1240x1240px; wide-field fundus photograph from neonatal ROP screening.
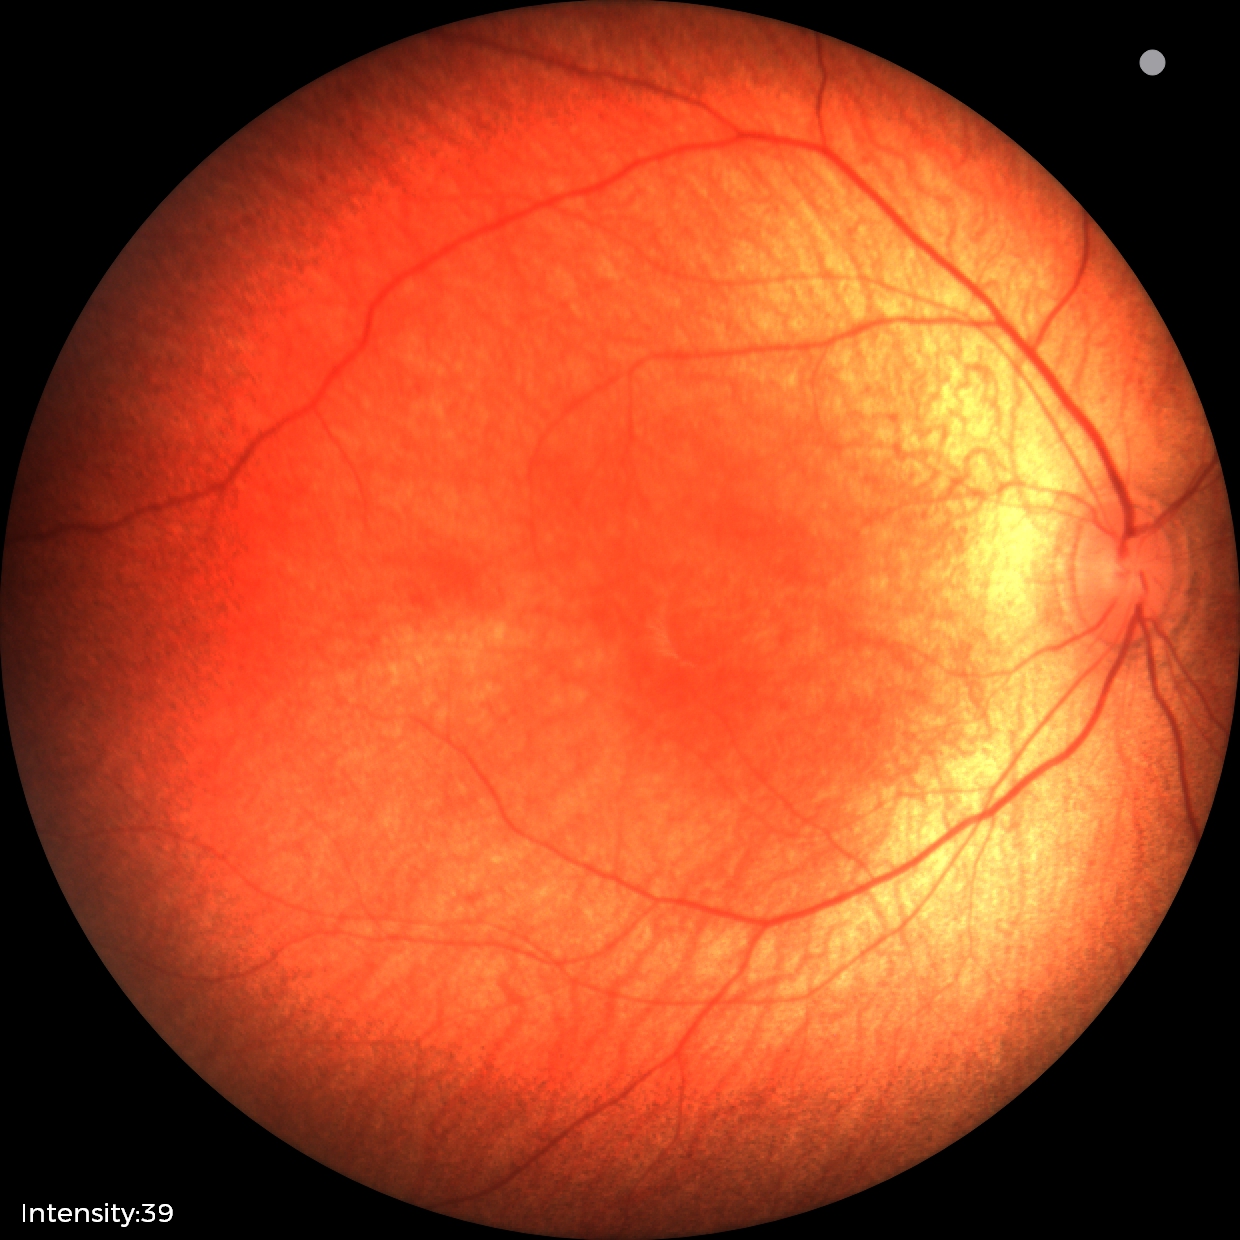 Assessment: physiological finding.